Acquired on the Phoenix ICON · pediatric retinal photograph (wide-field).
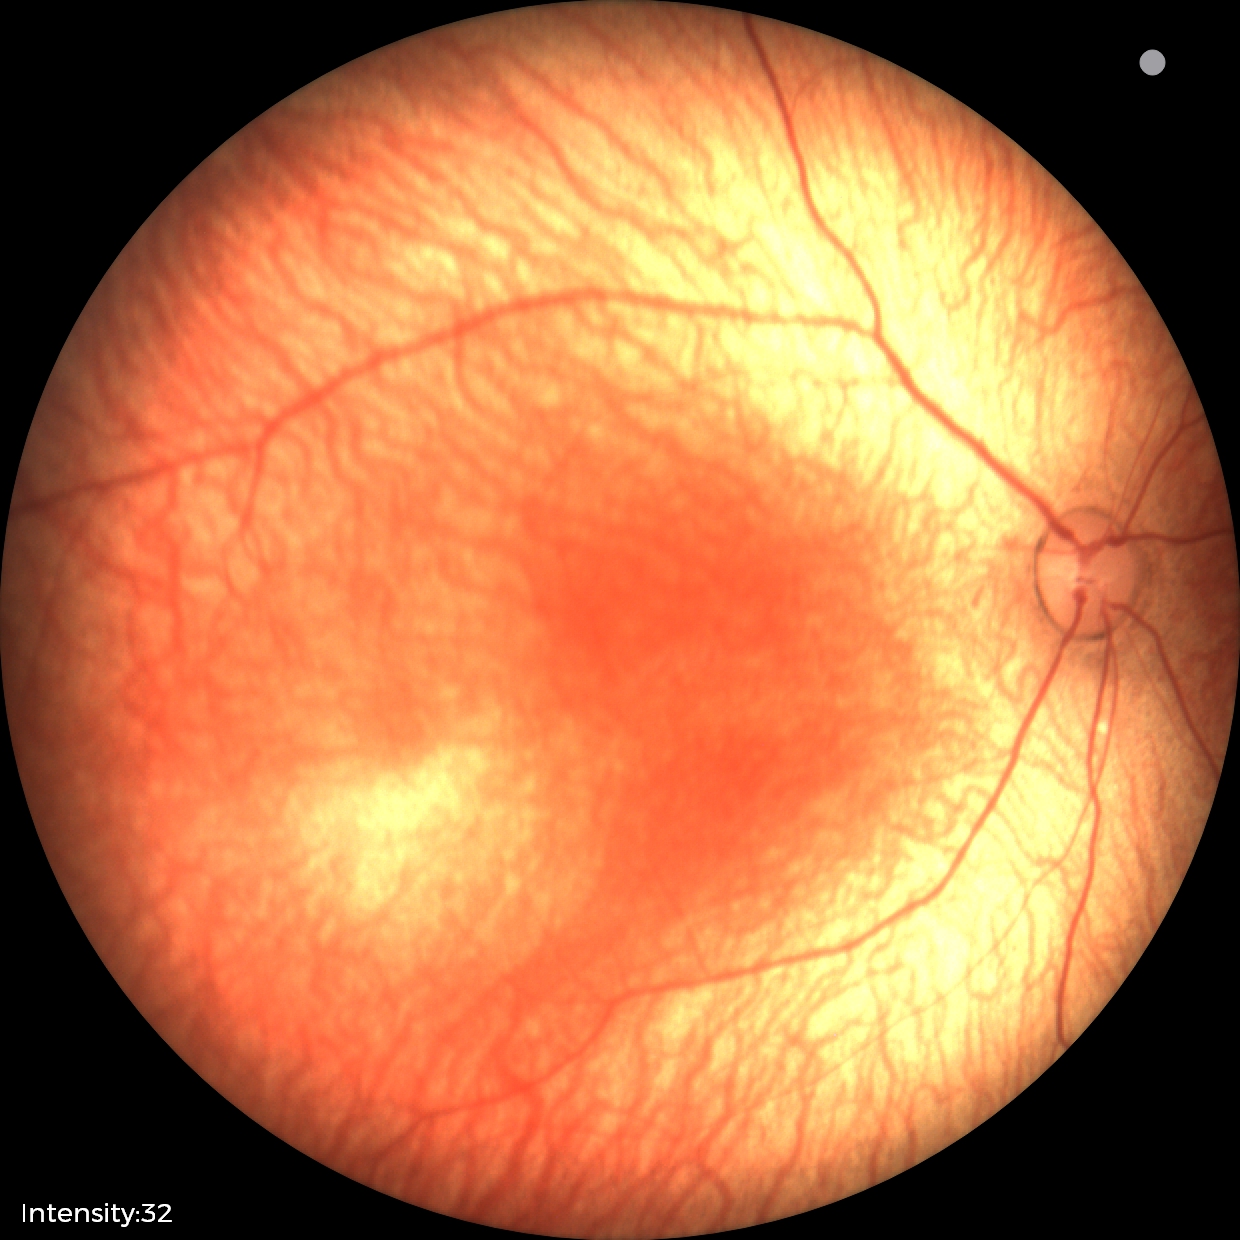
Screening examination diagnosed as physiological.